Camera: NIDEK AFC-230. Color fundus photograph. 848x848px:
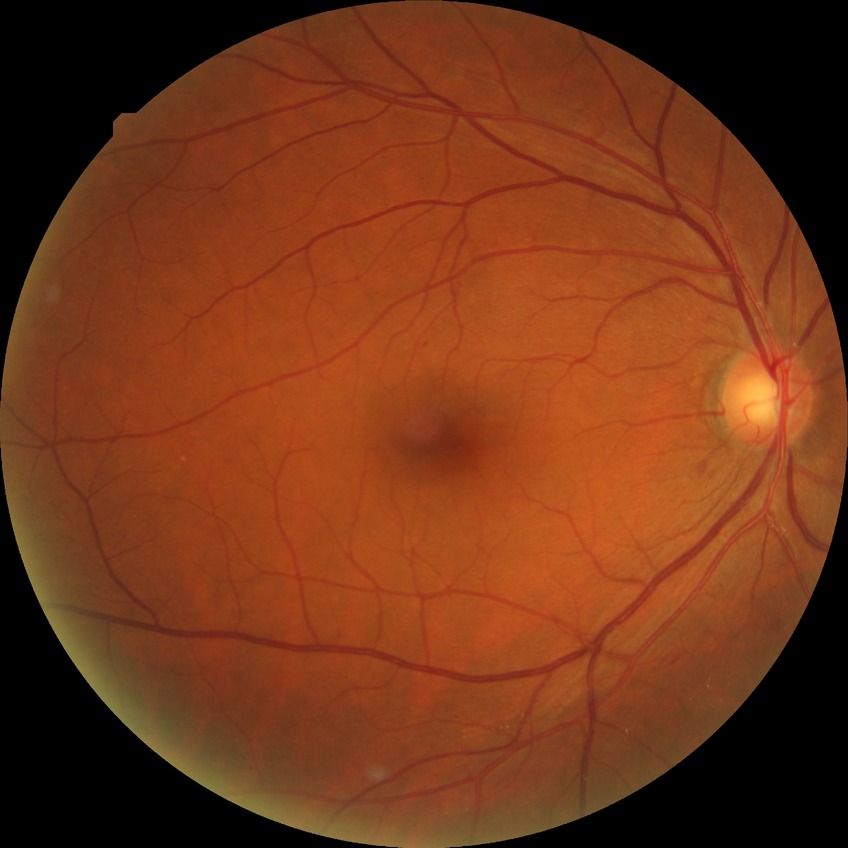

Diabetic retinopathy (DR) is simple diabetic retinopathy (SDR).